45° FOV
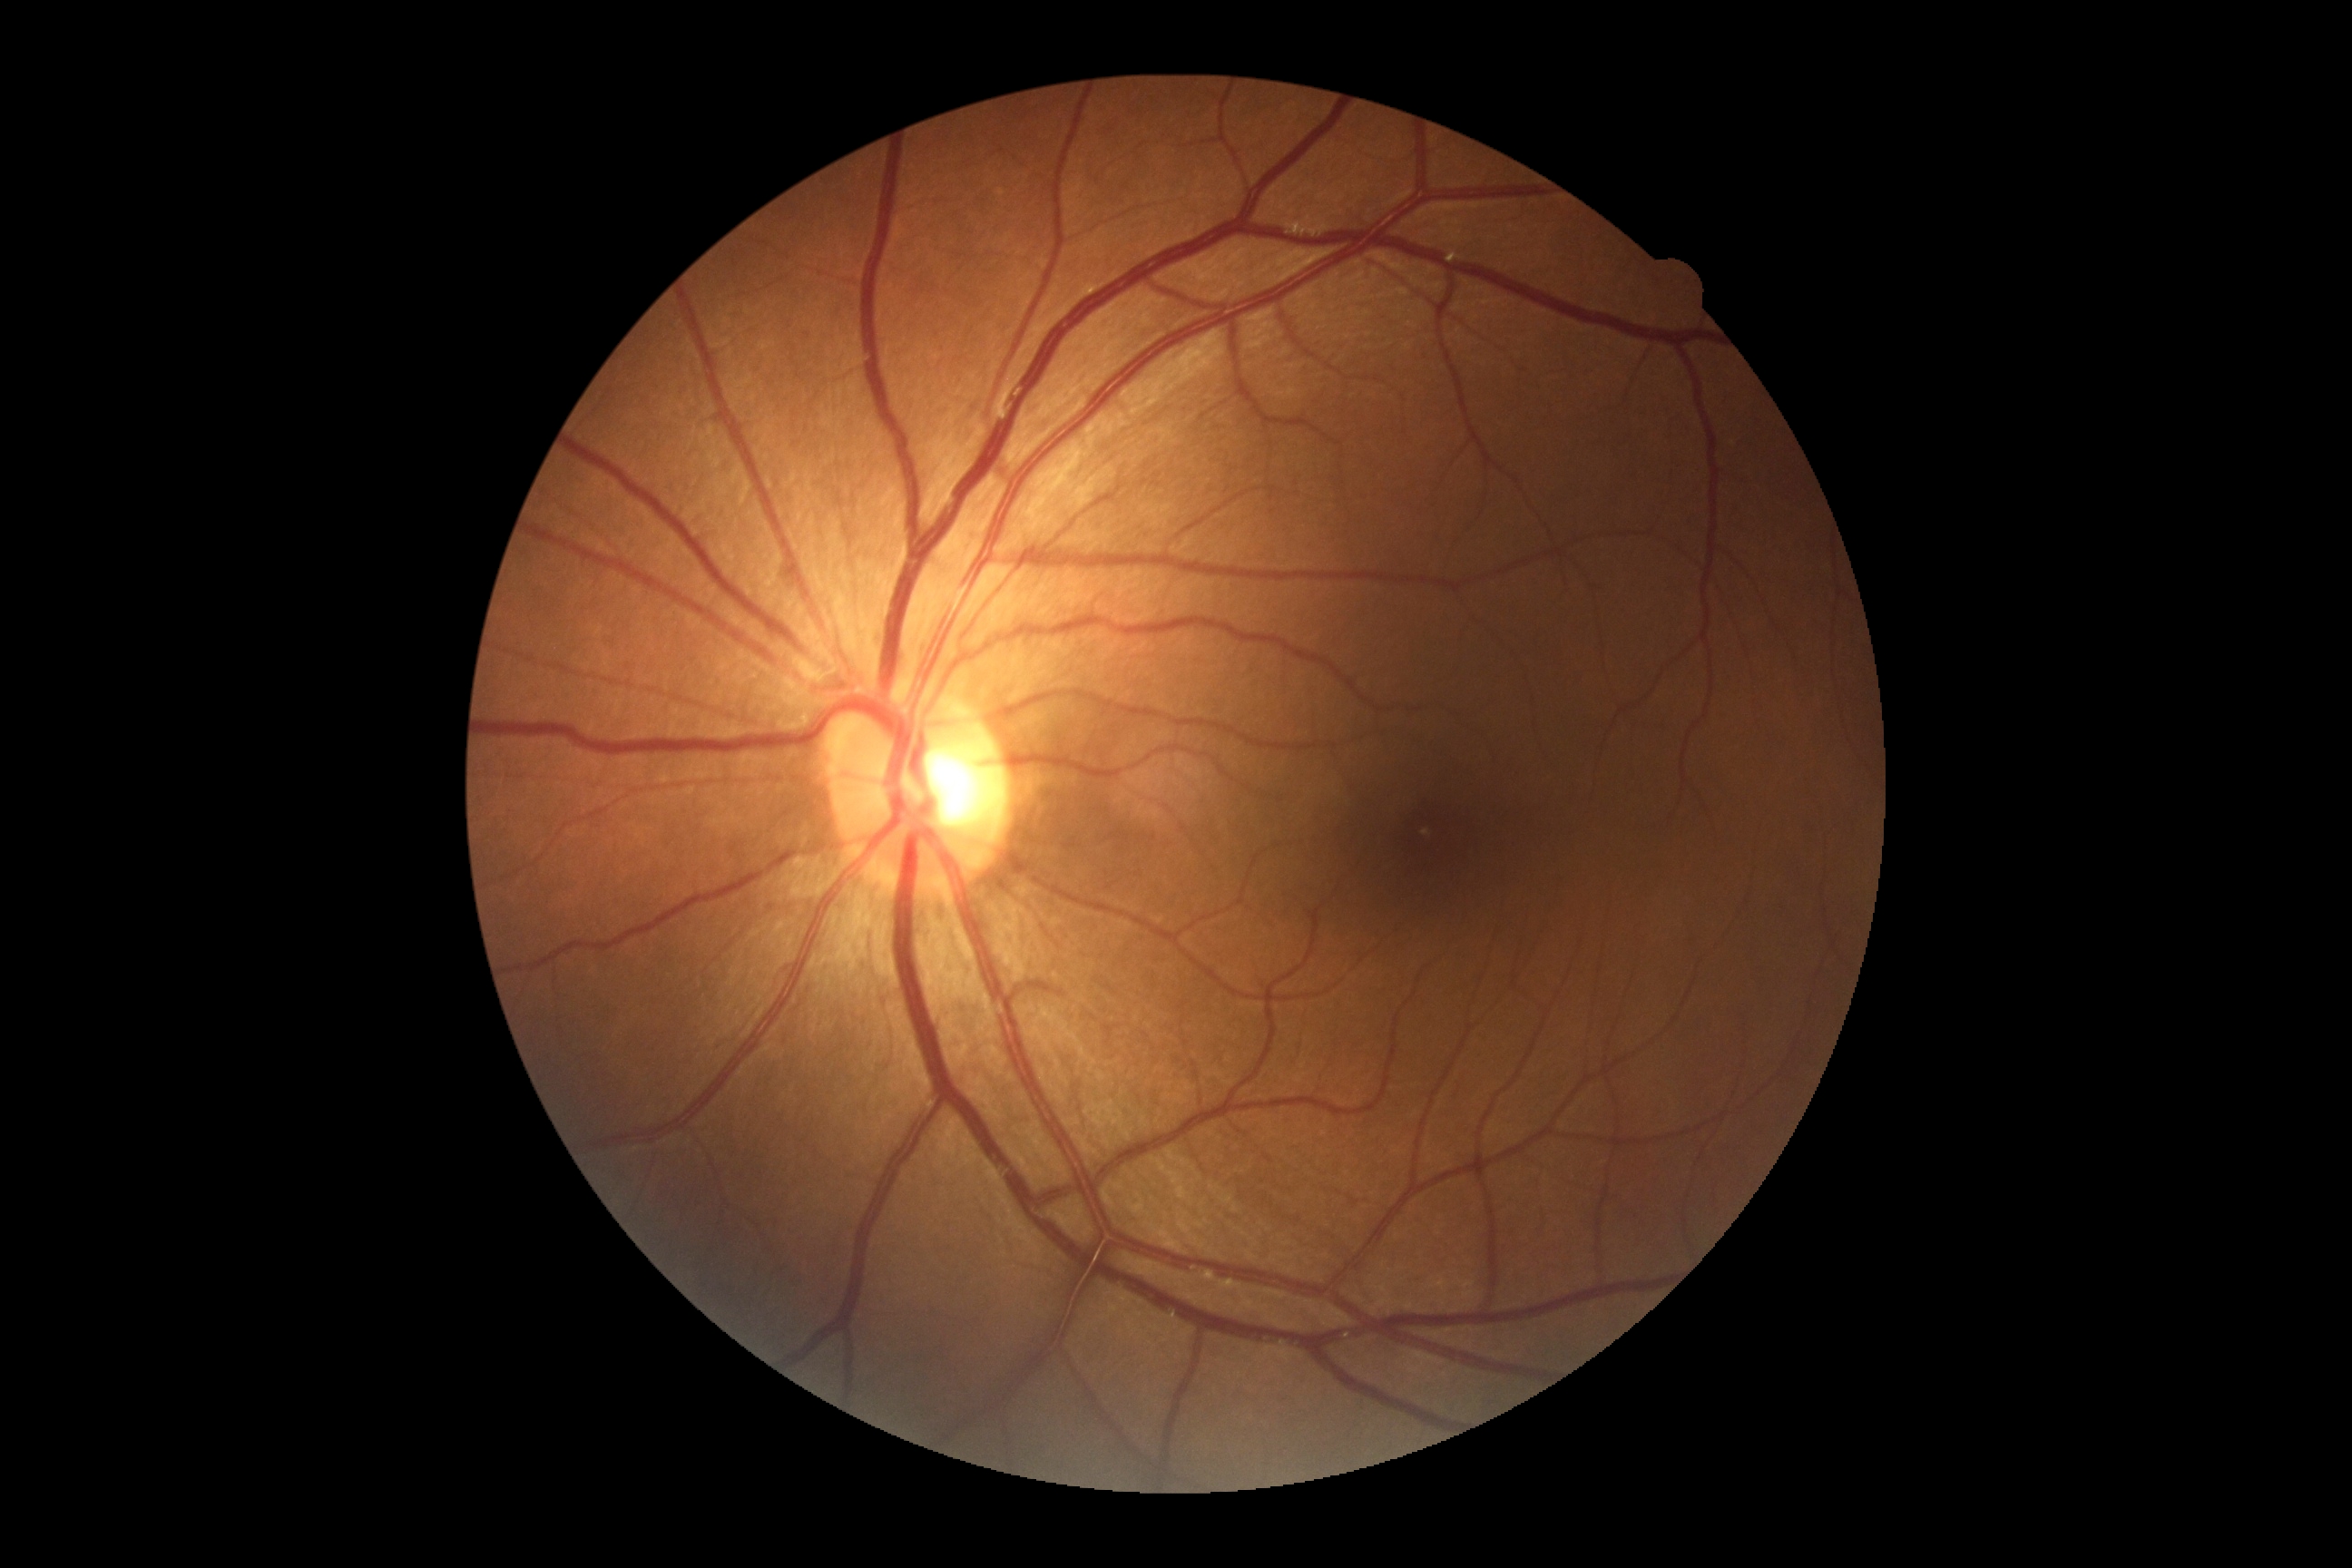
DR stage is no apparent retinopathy (grade 0).